45° field of view:
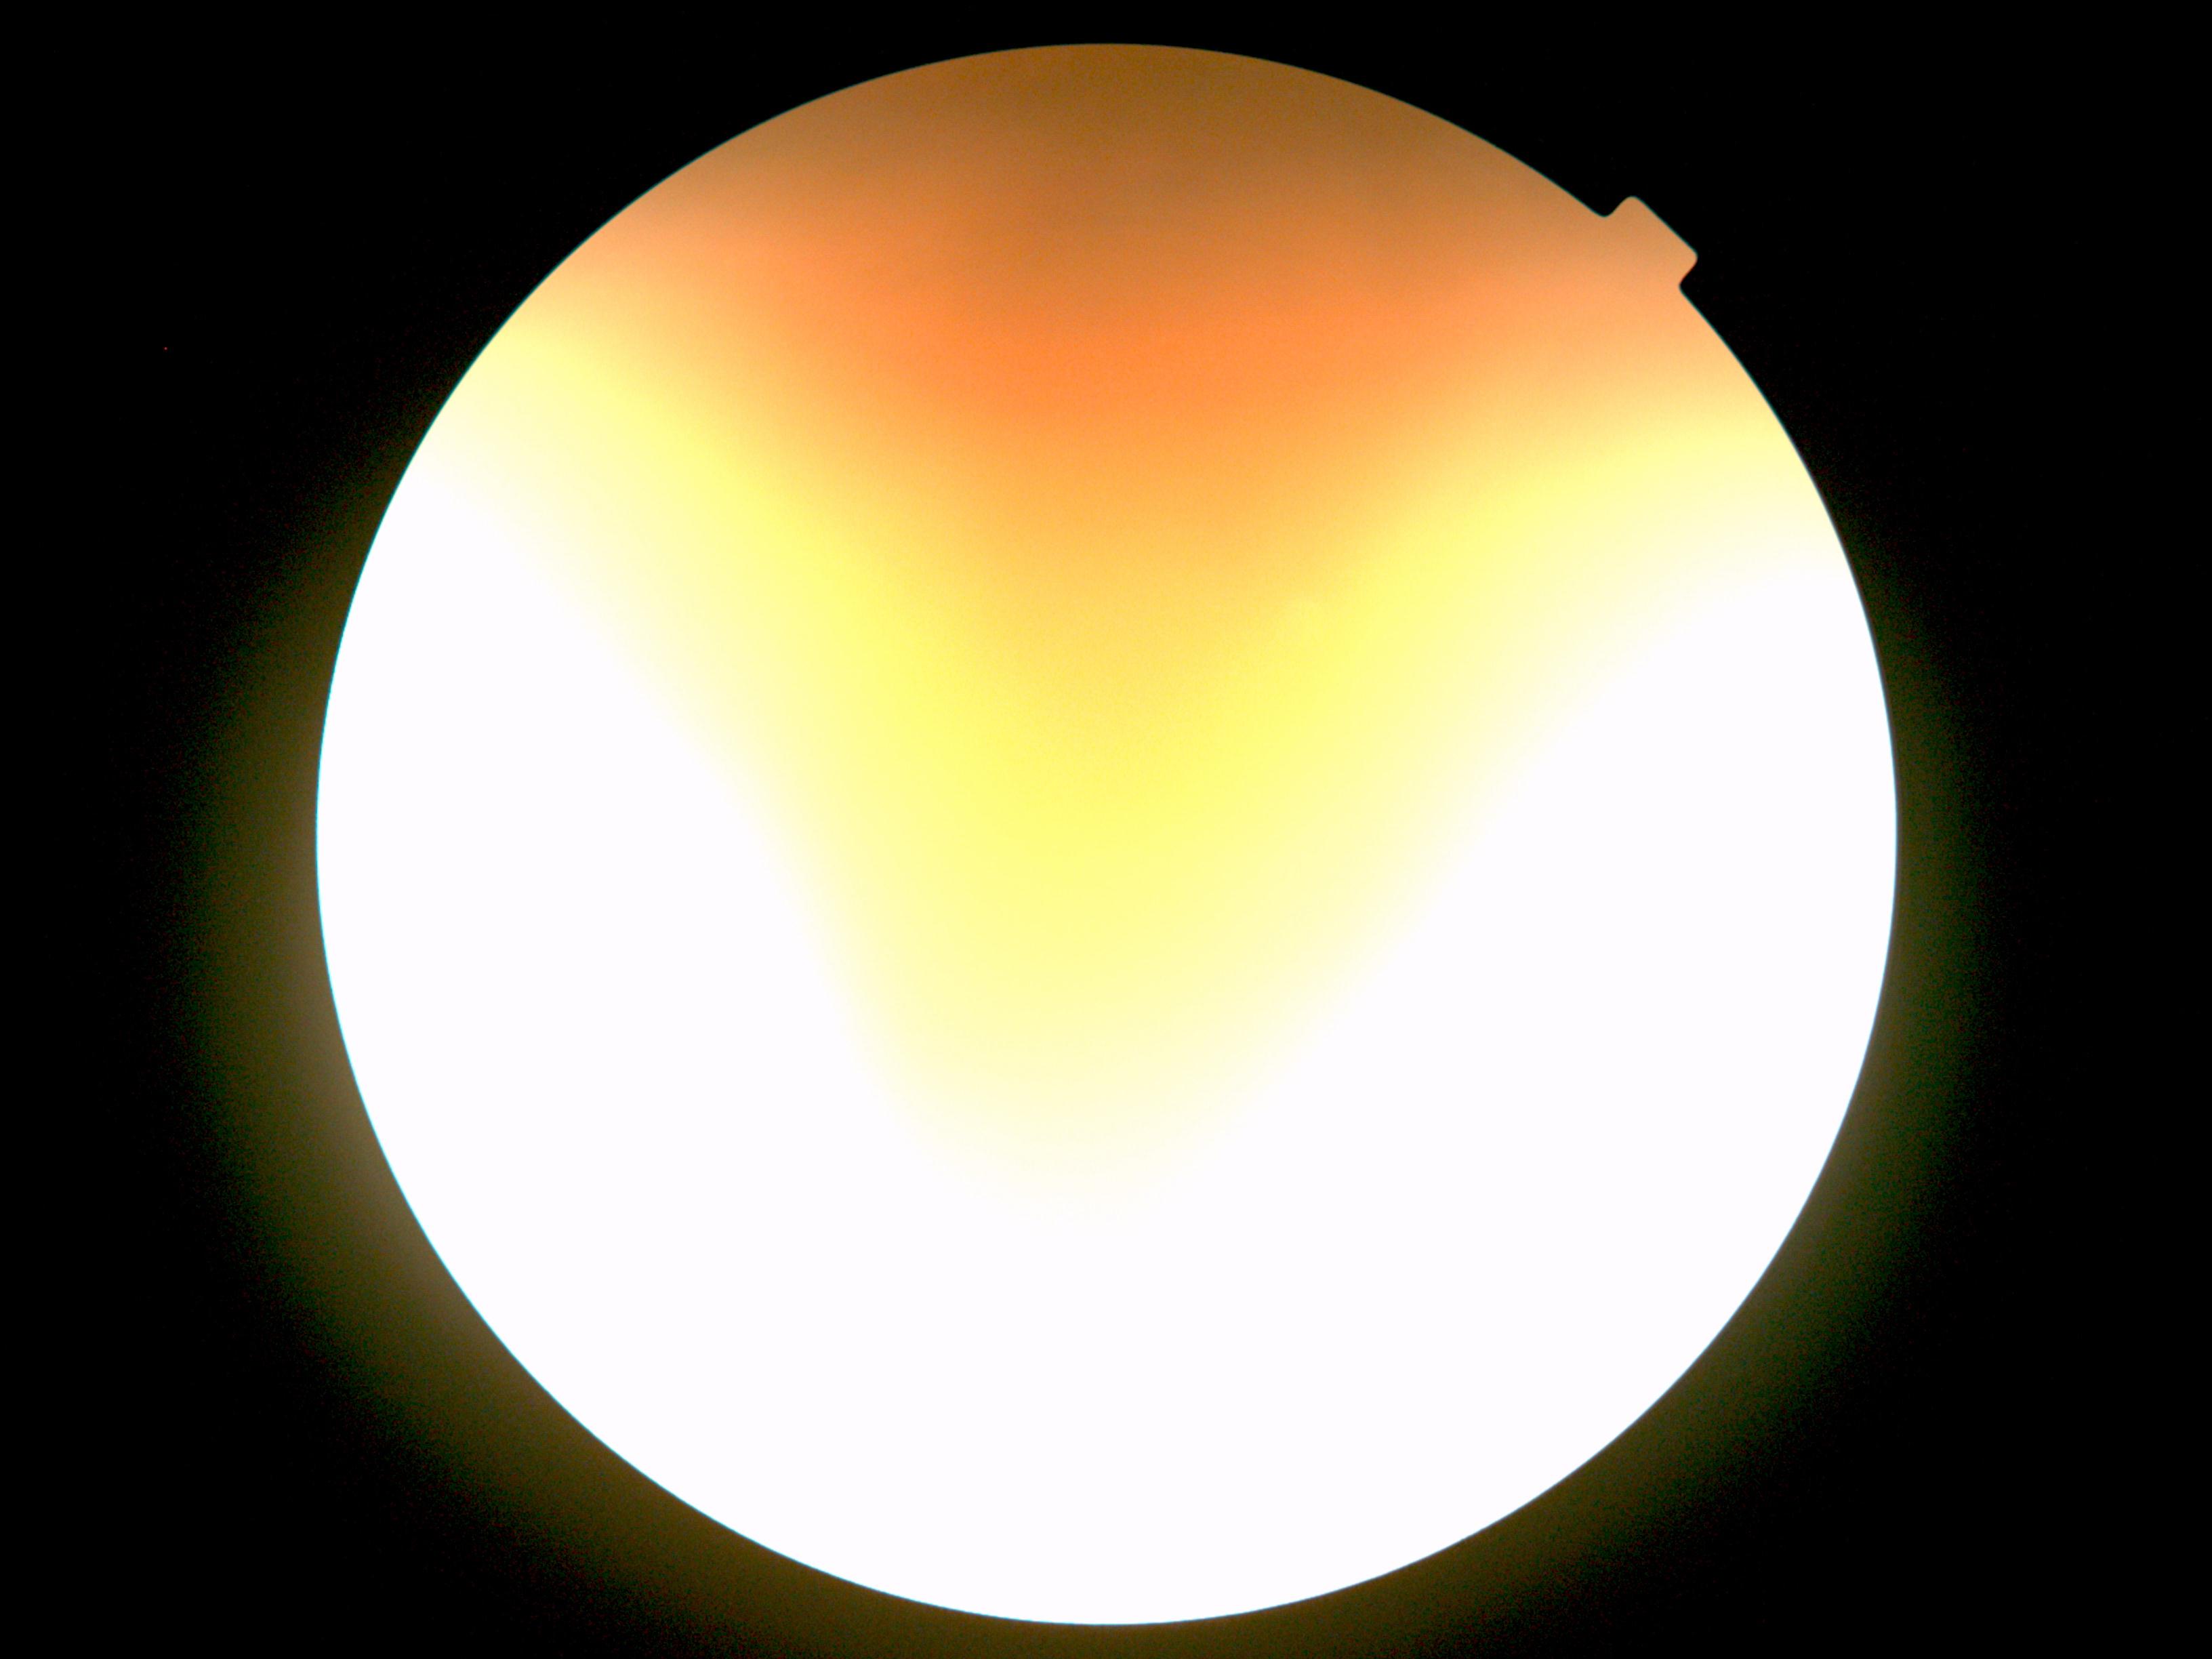 DR stage: ungradable due to poor image quality.